2352 x 1568 pixels
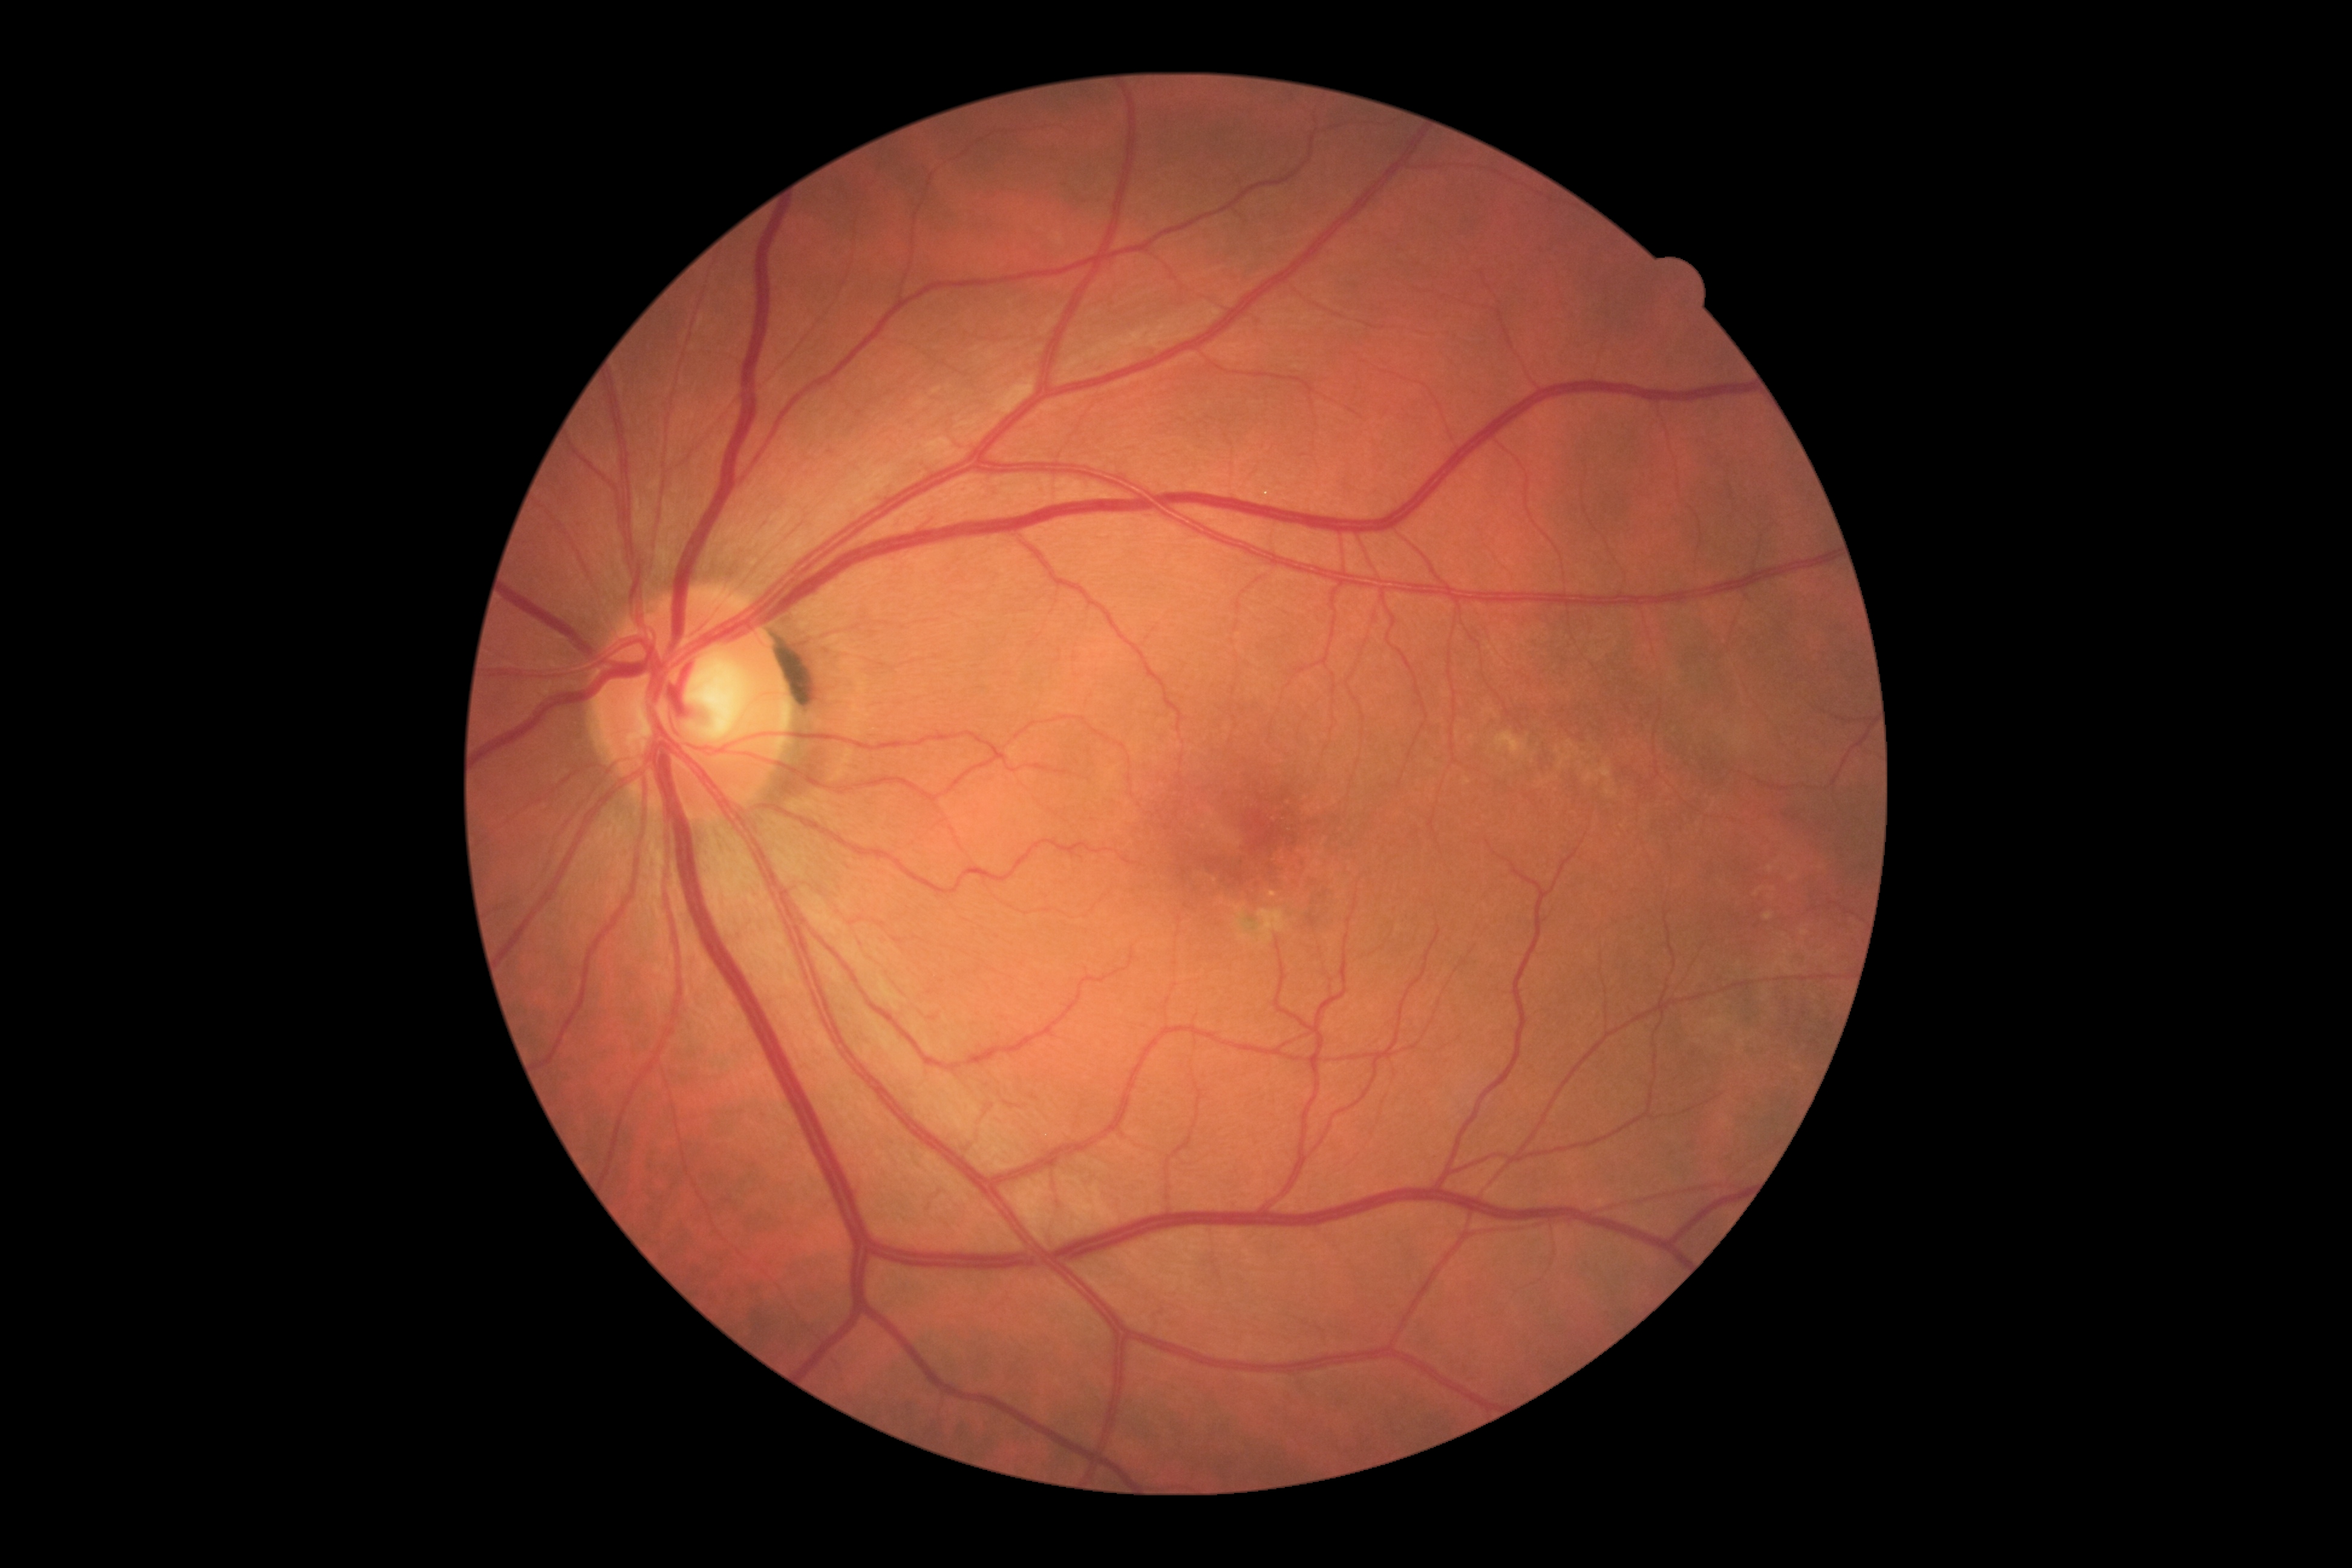 DR grade=0 (no apparent retinopathy).